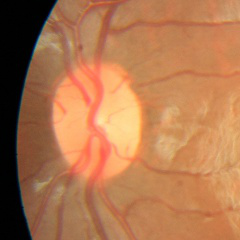 Assessment: no evidence of glaucoma.